Color fundus photograph:
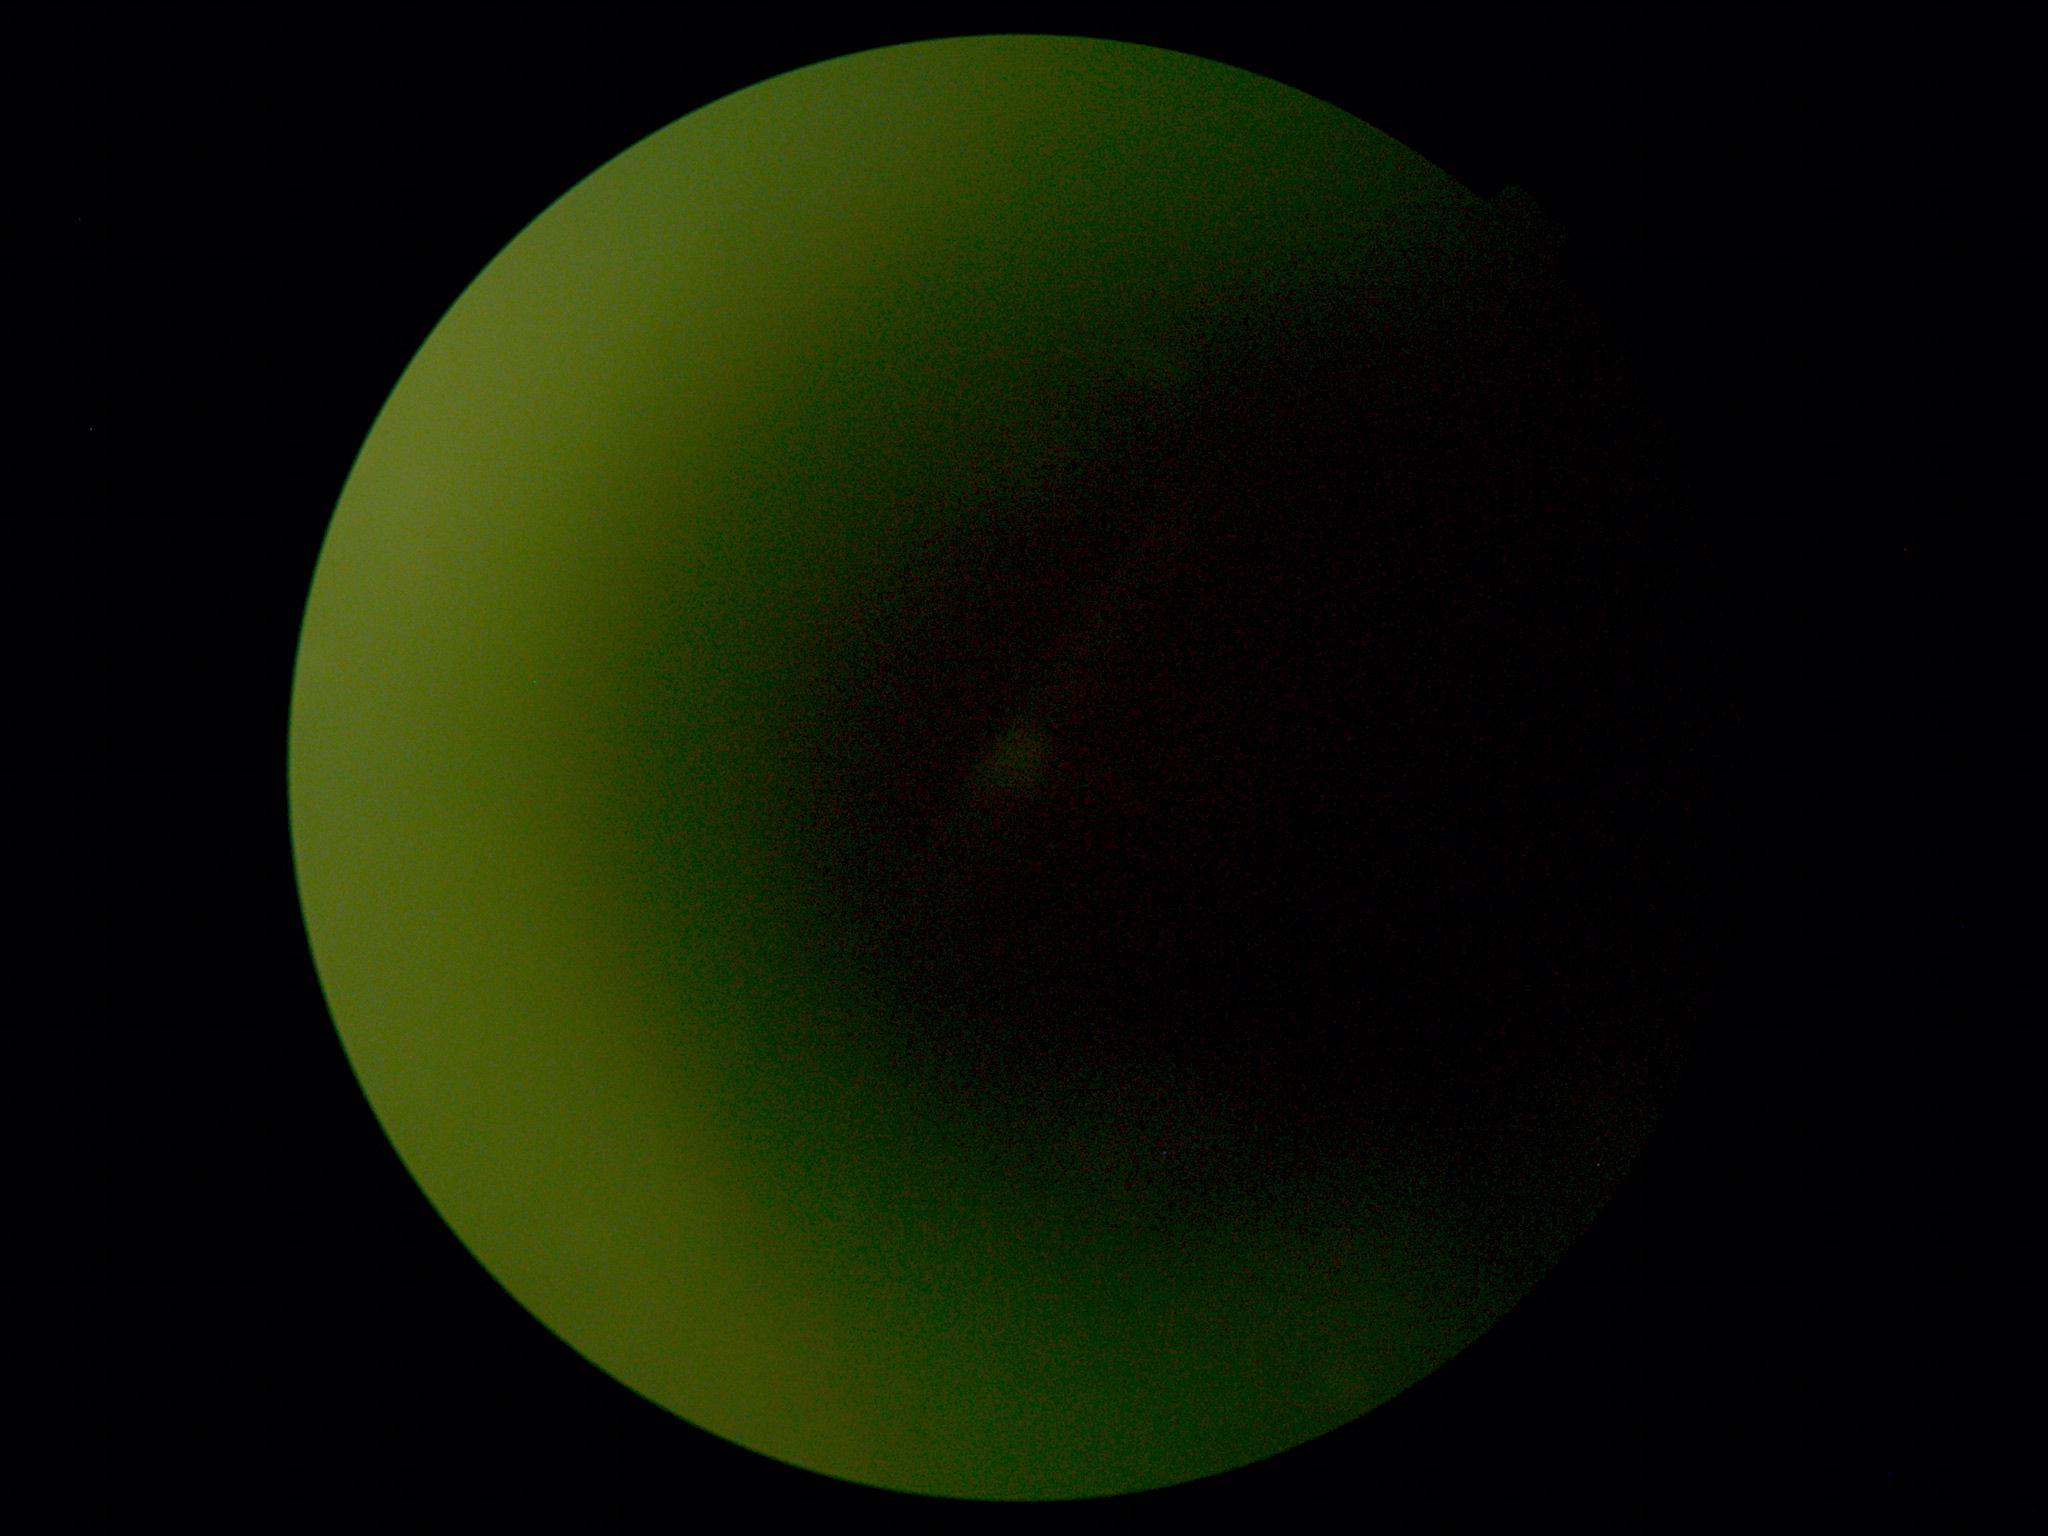

Ungradable image — DR severity cannot be determined.
Diabetic retinopathy (DR) is ungradable due to poor image quality.